45° FOV
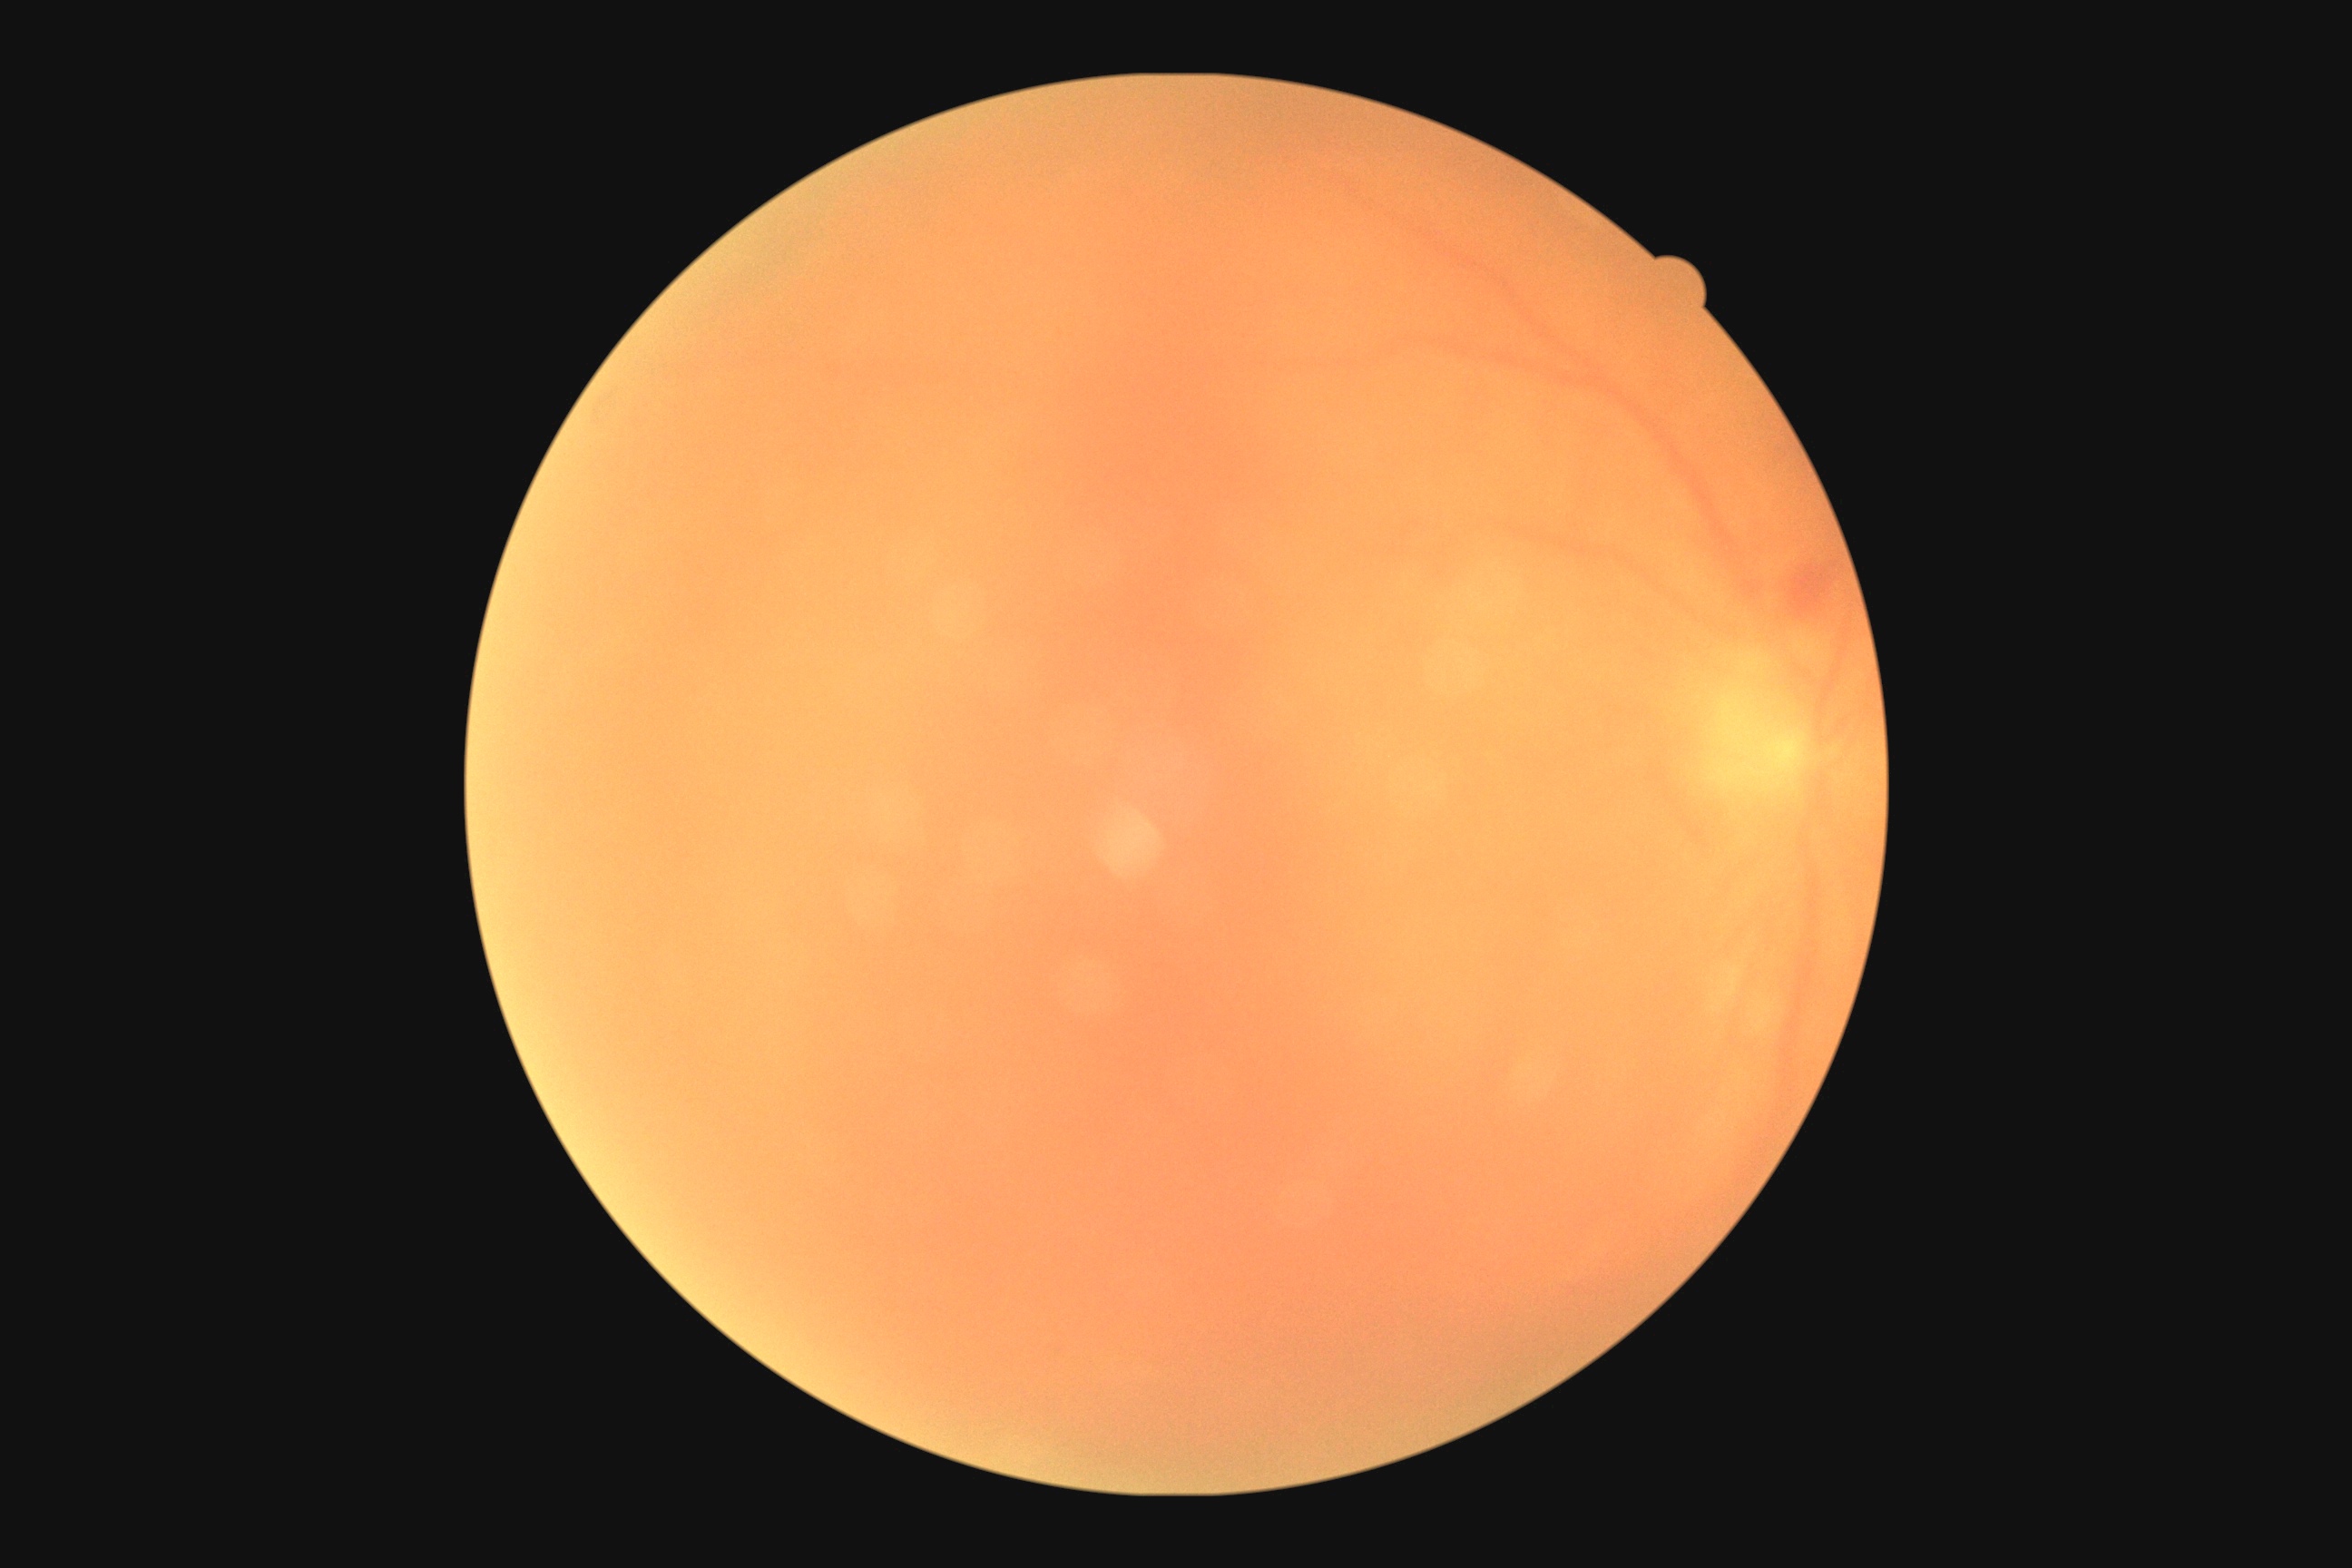
diabetic retinopathy@2.